Retinal fundus photograph — 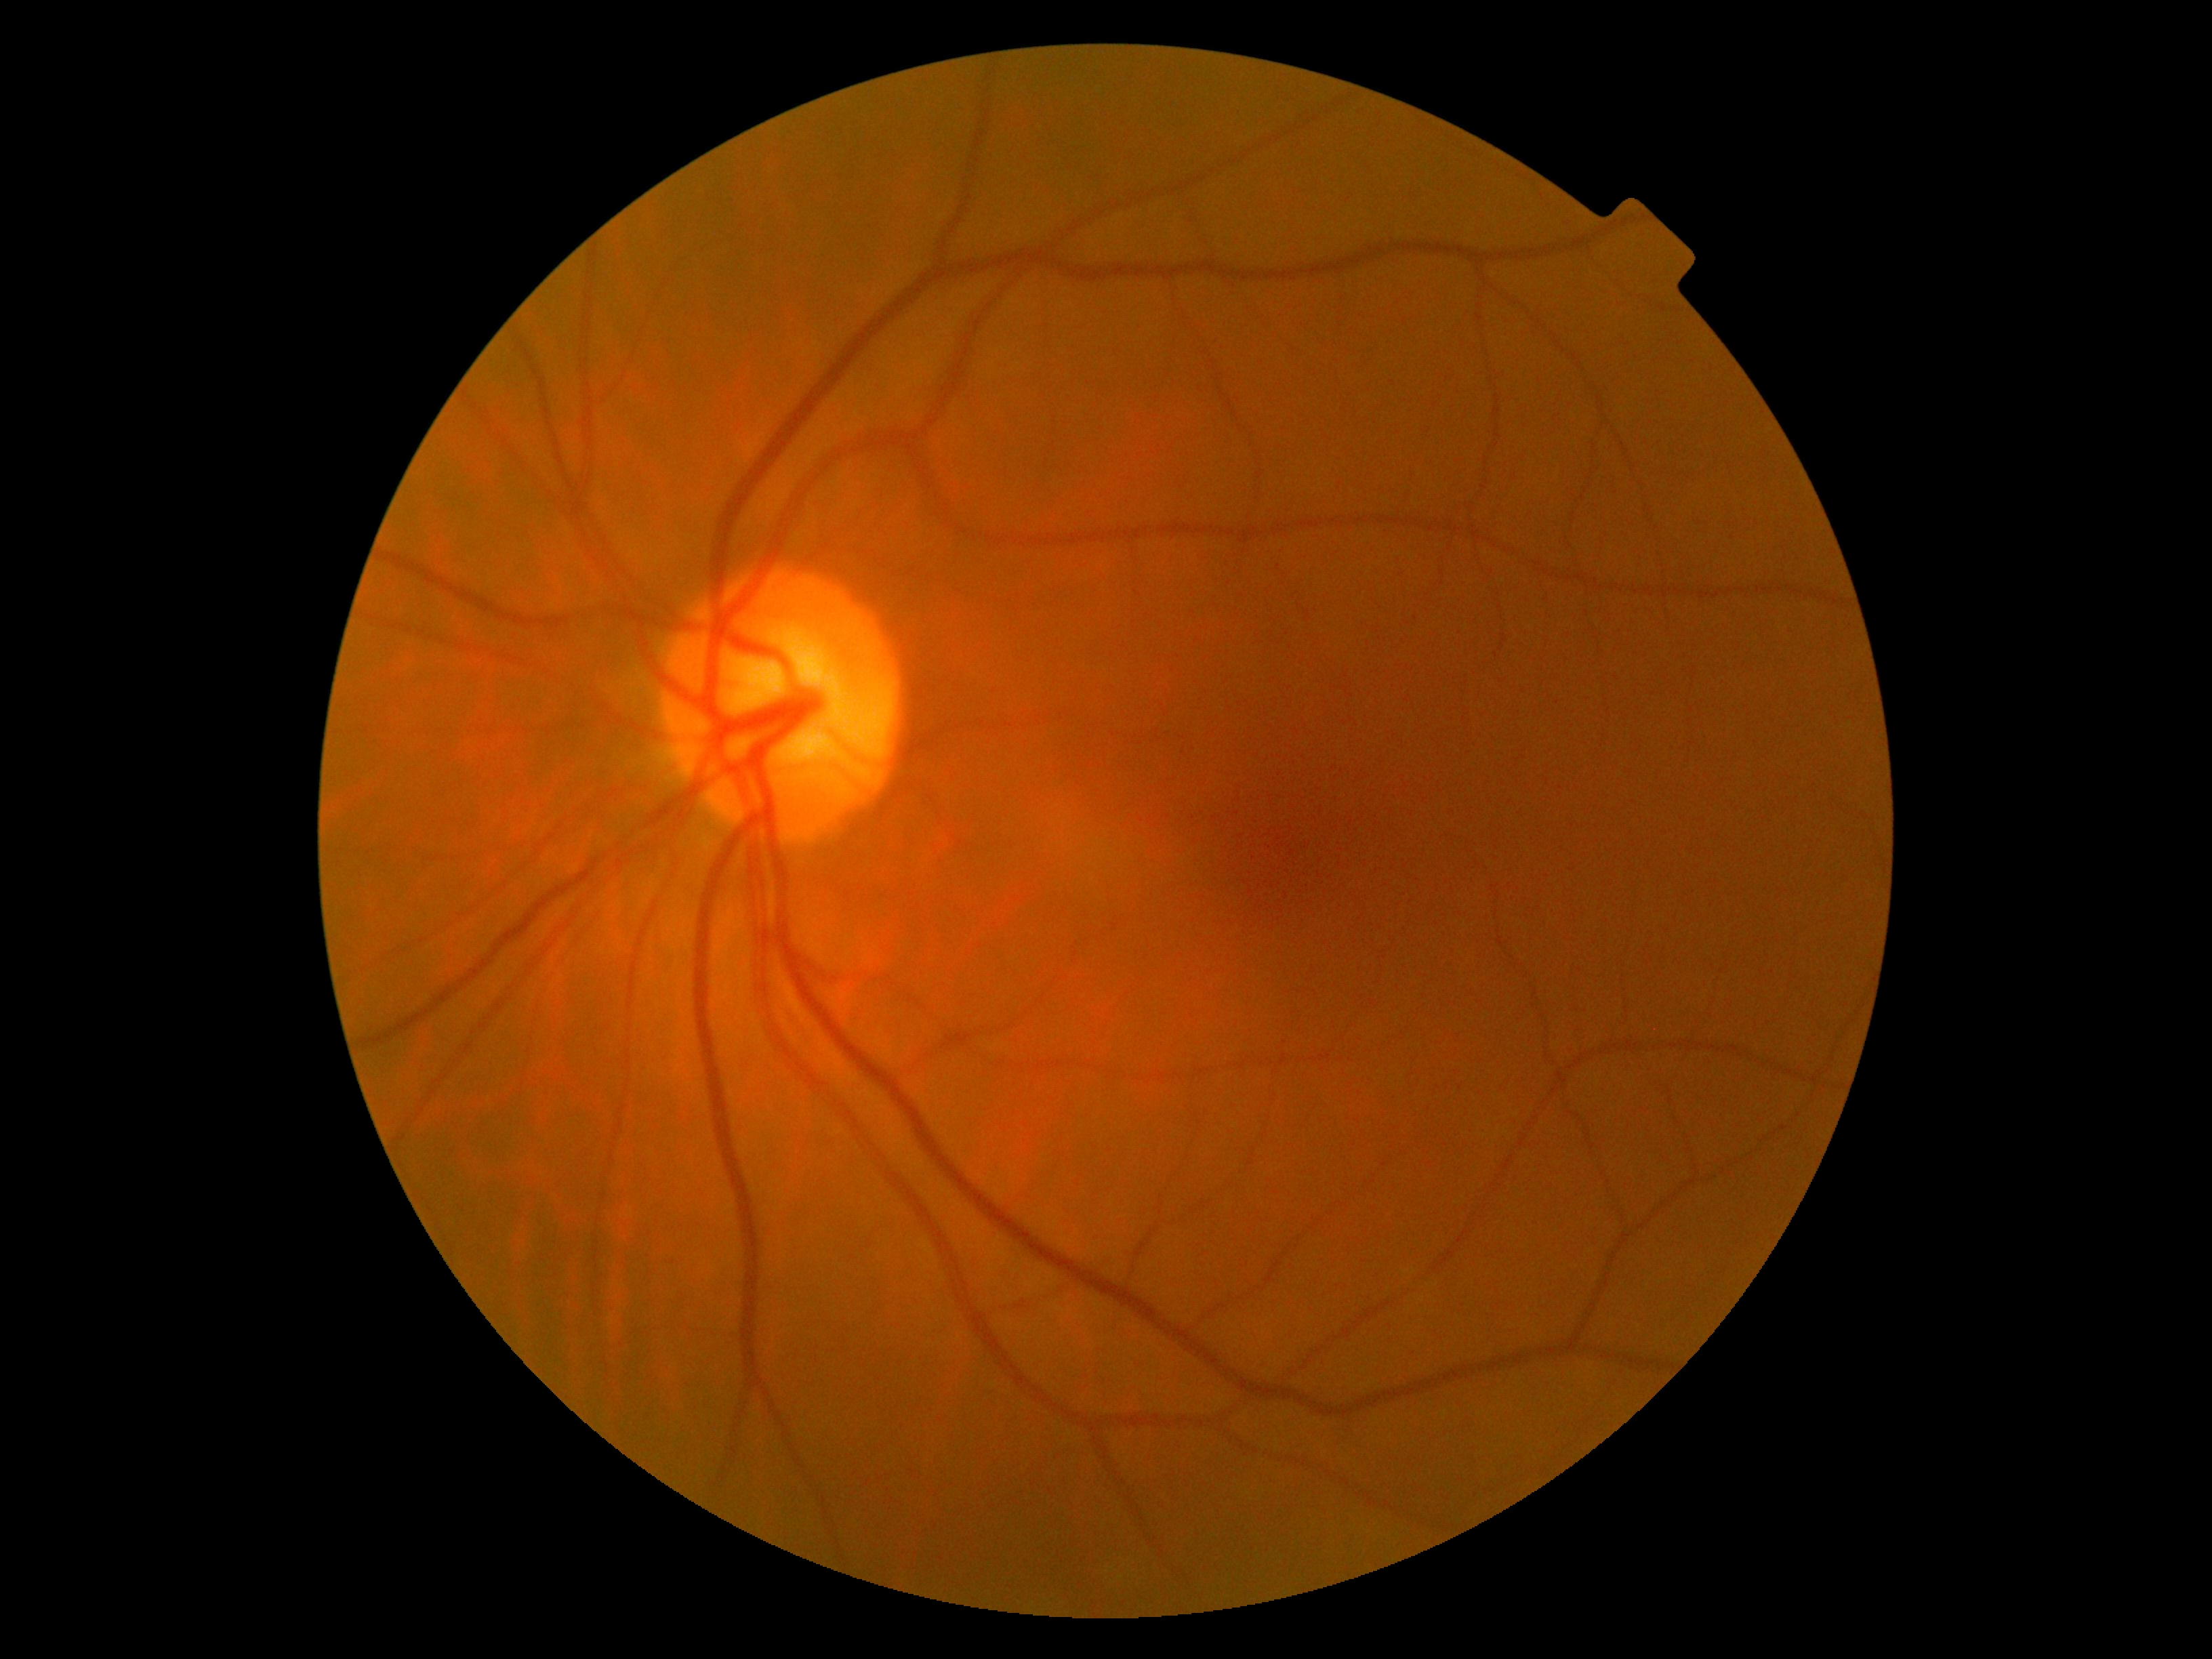 Diabetic retinopathy severity is no apparent diabetic retinopathy (grade 0).